45-degree field of view: 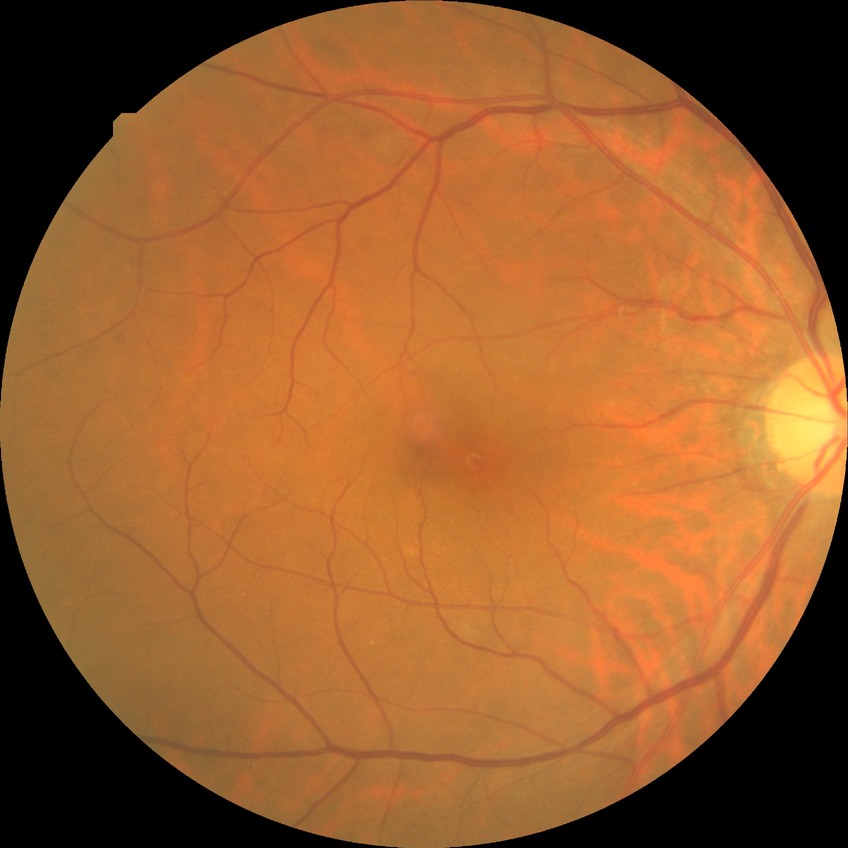
DR stage=SDR.